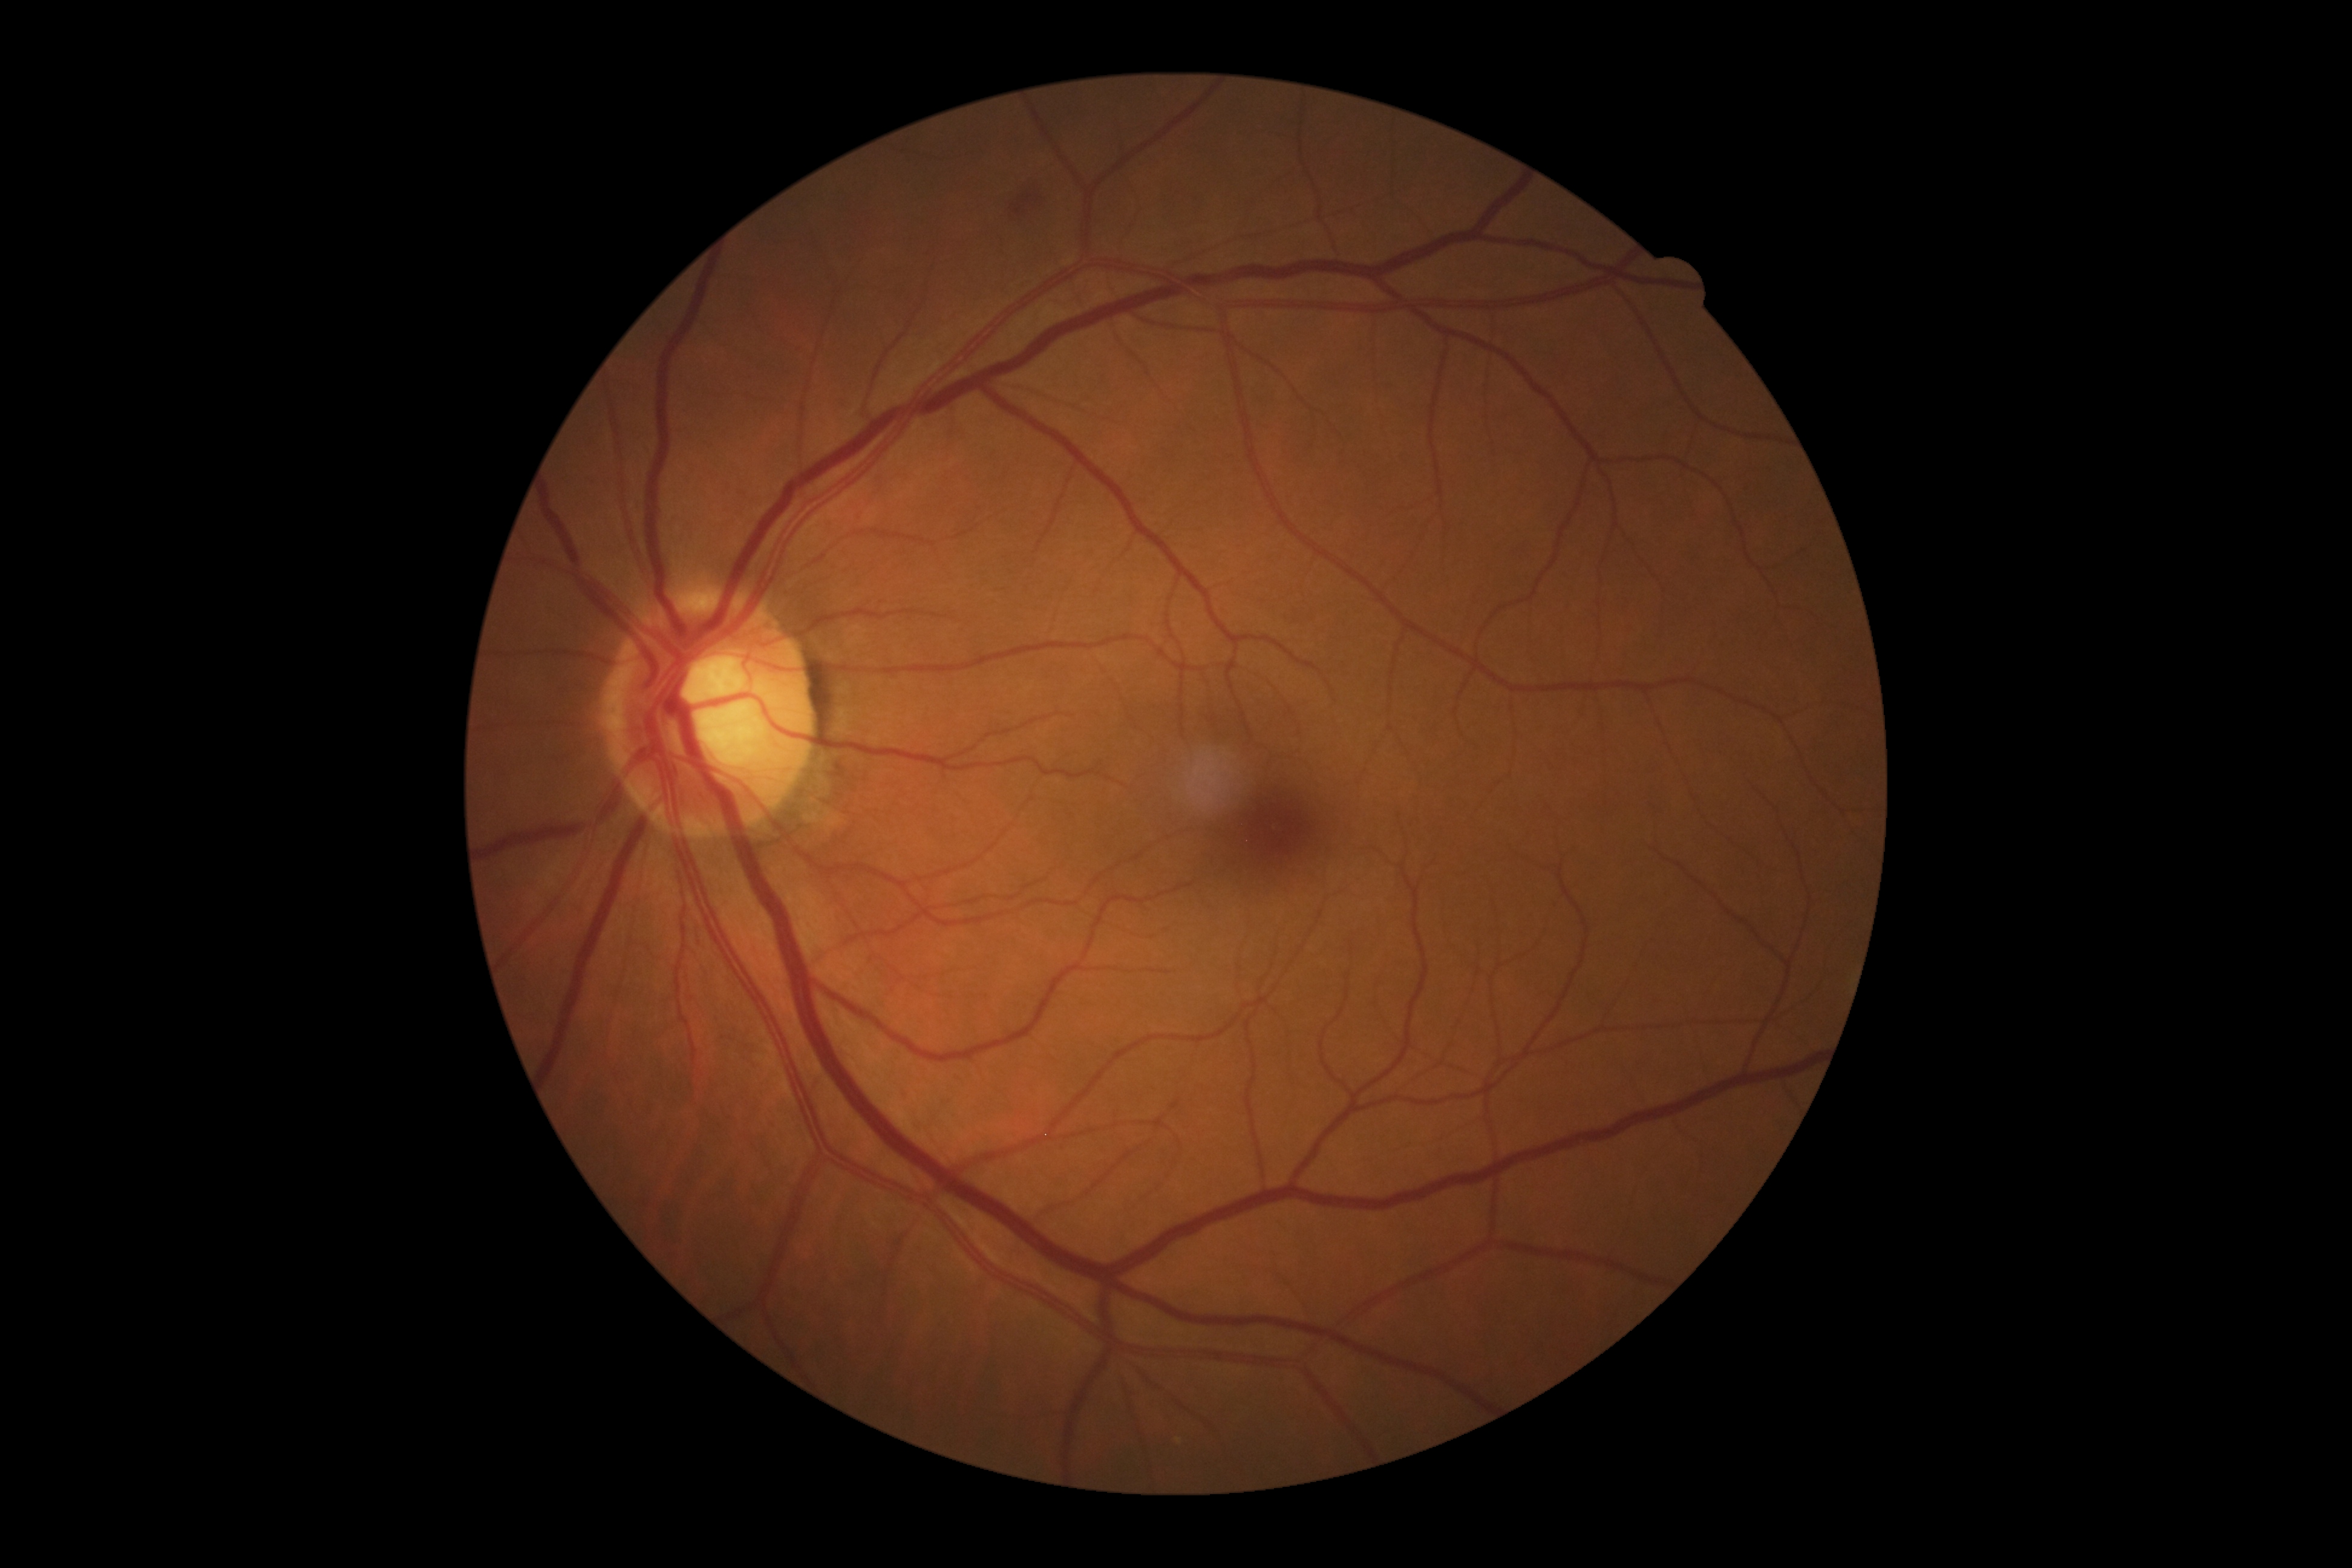 {"dr_grade": "2"}